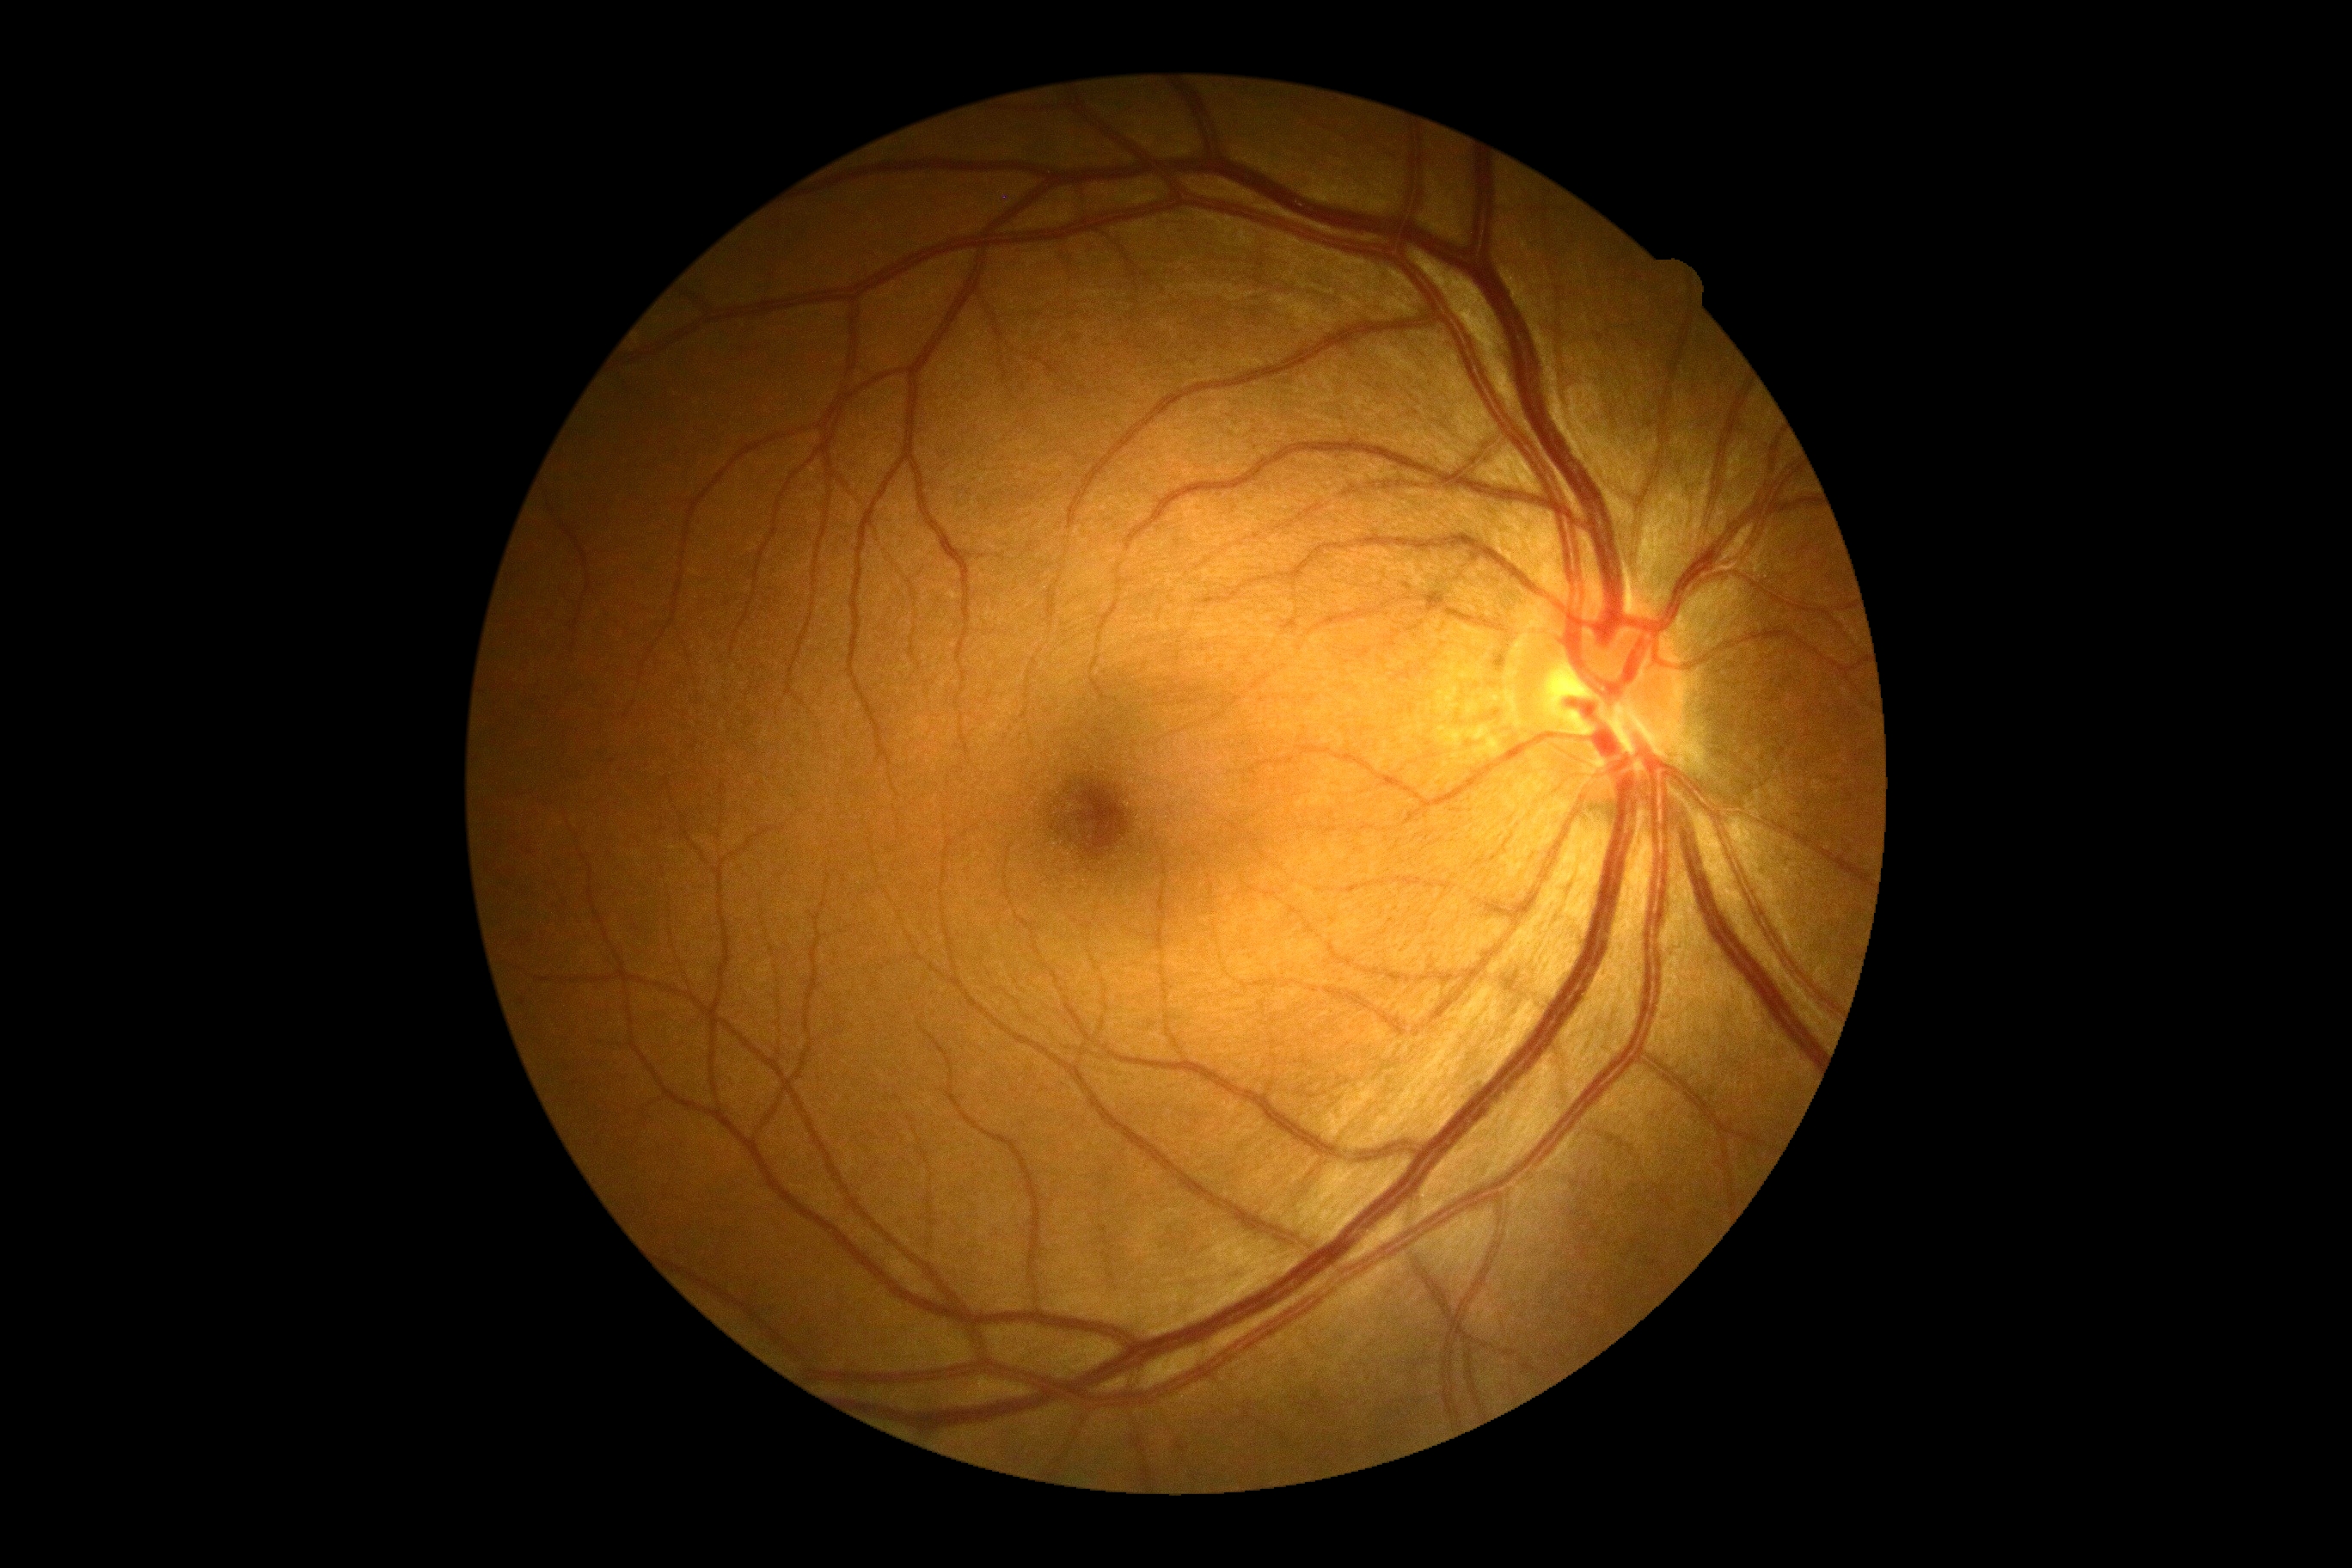
{
  "dr_grade": "grade 0 (no apparent retinopathy)"
}